1240 x 1240 pixels · wide-field fundus photograph of an infant — 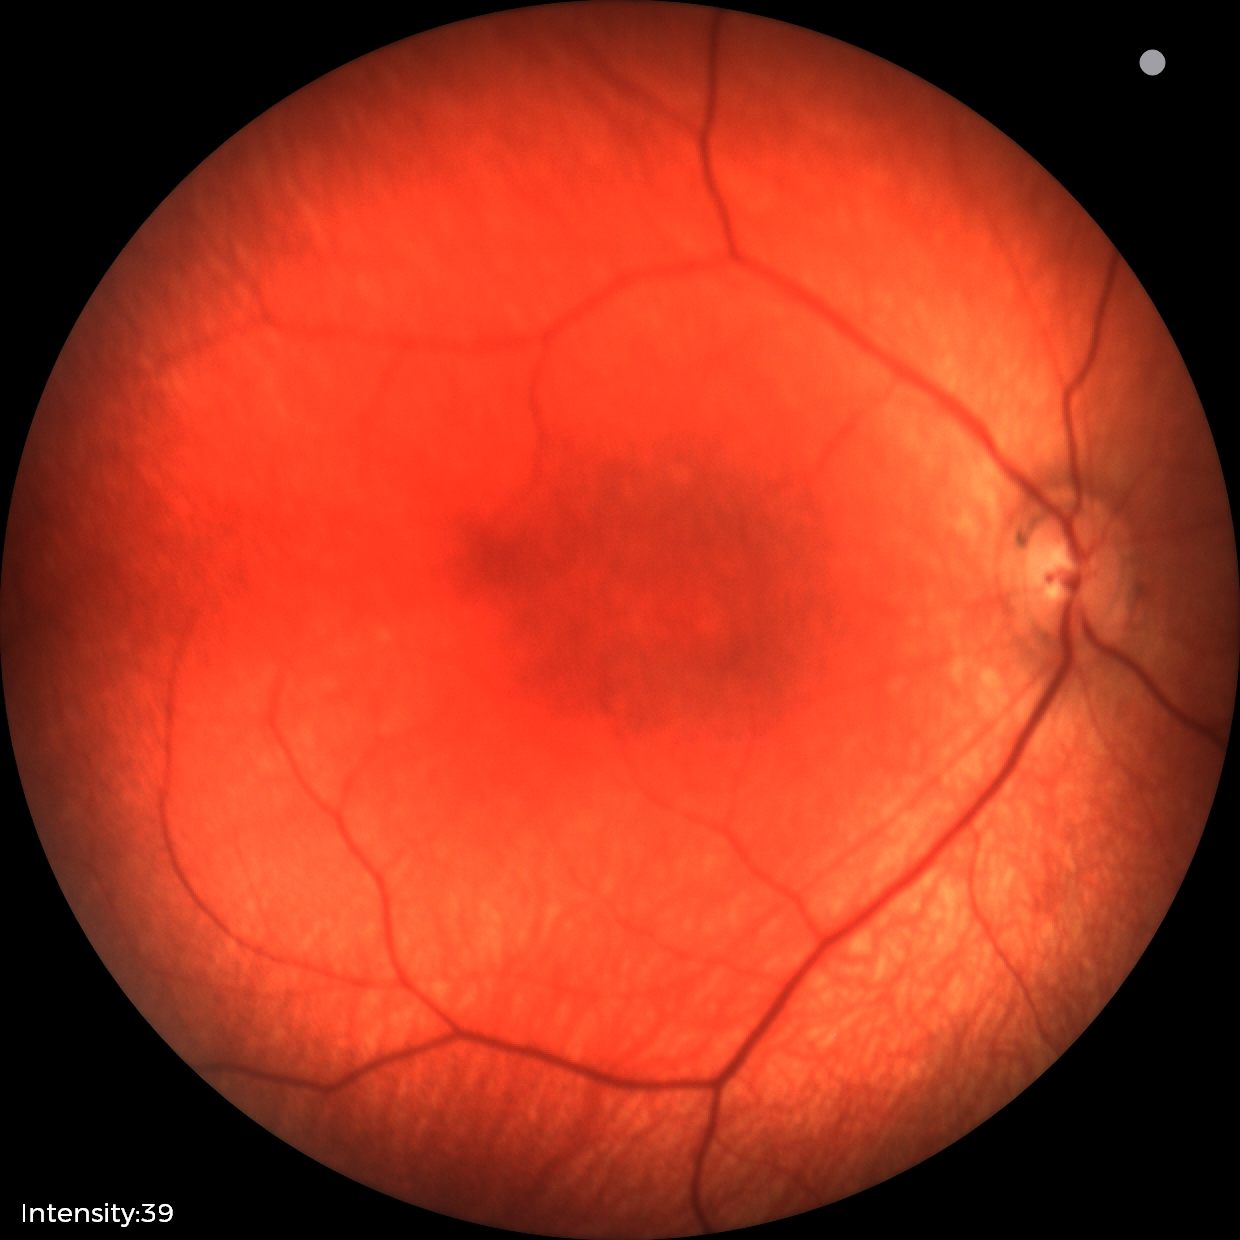 No retinal pathology identified on screening.